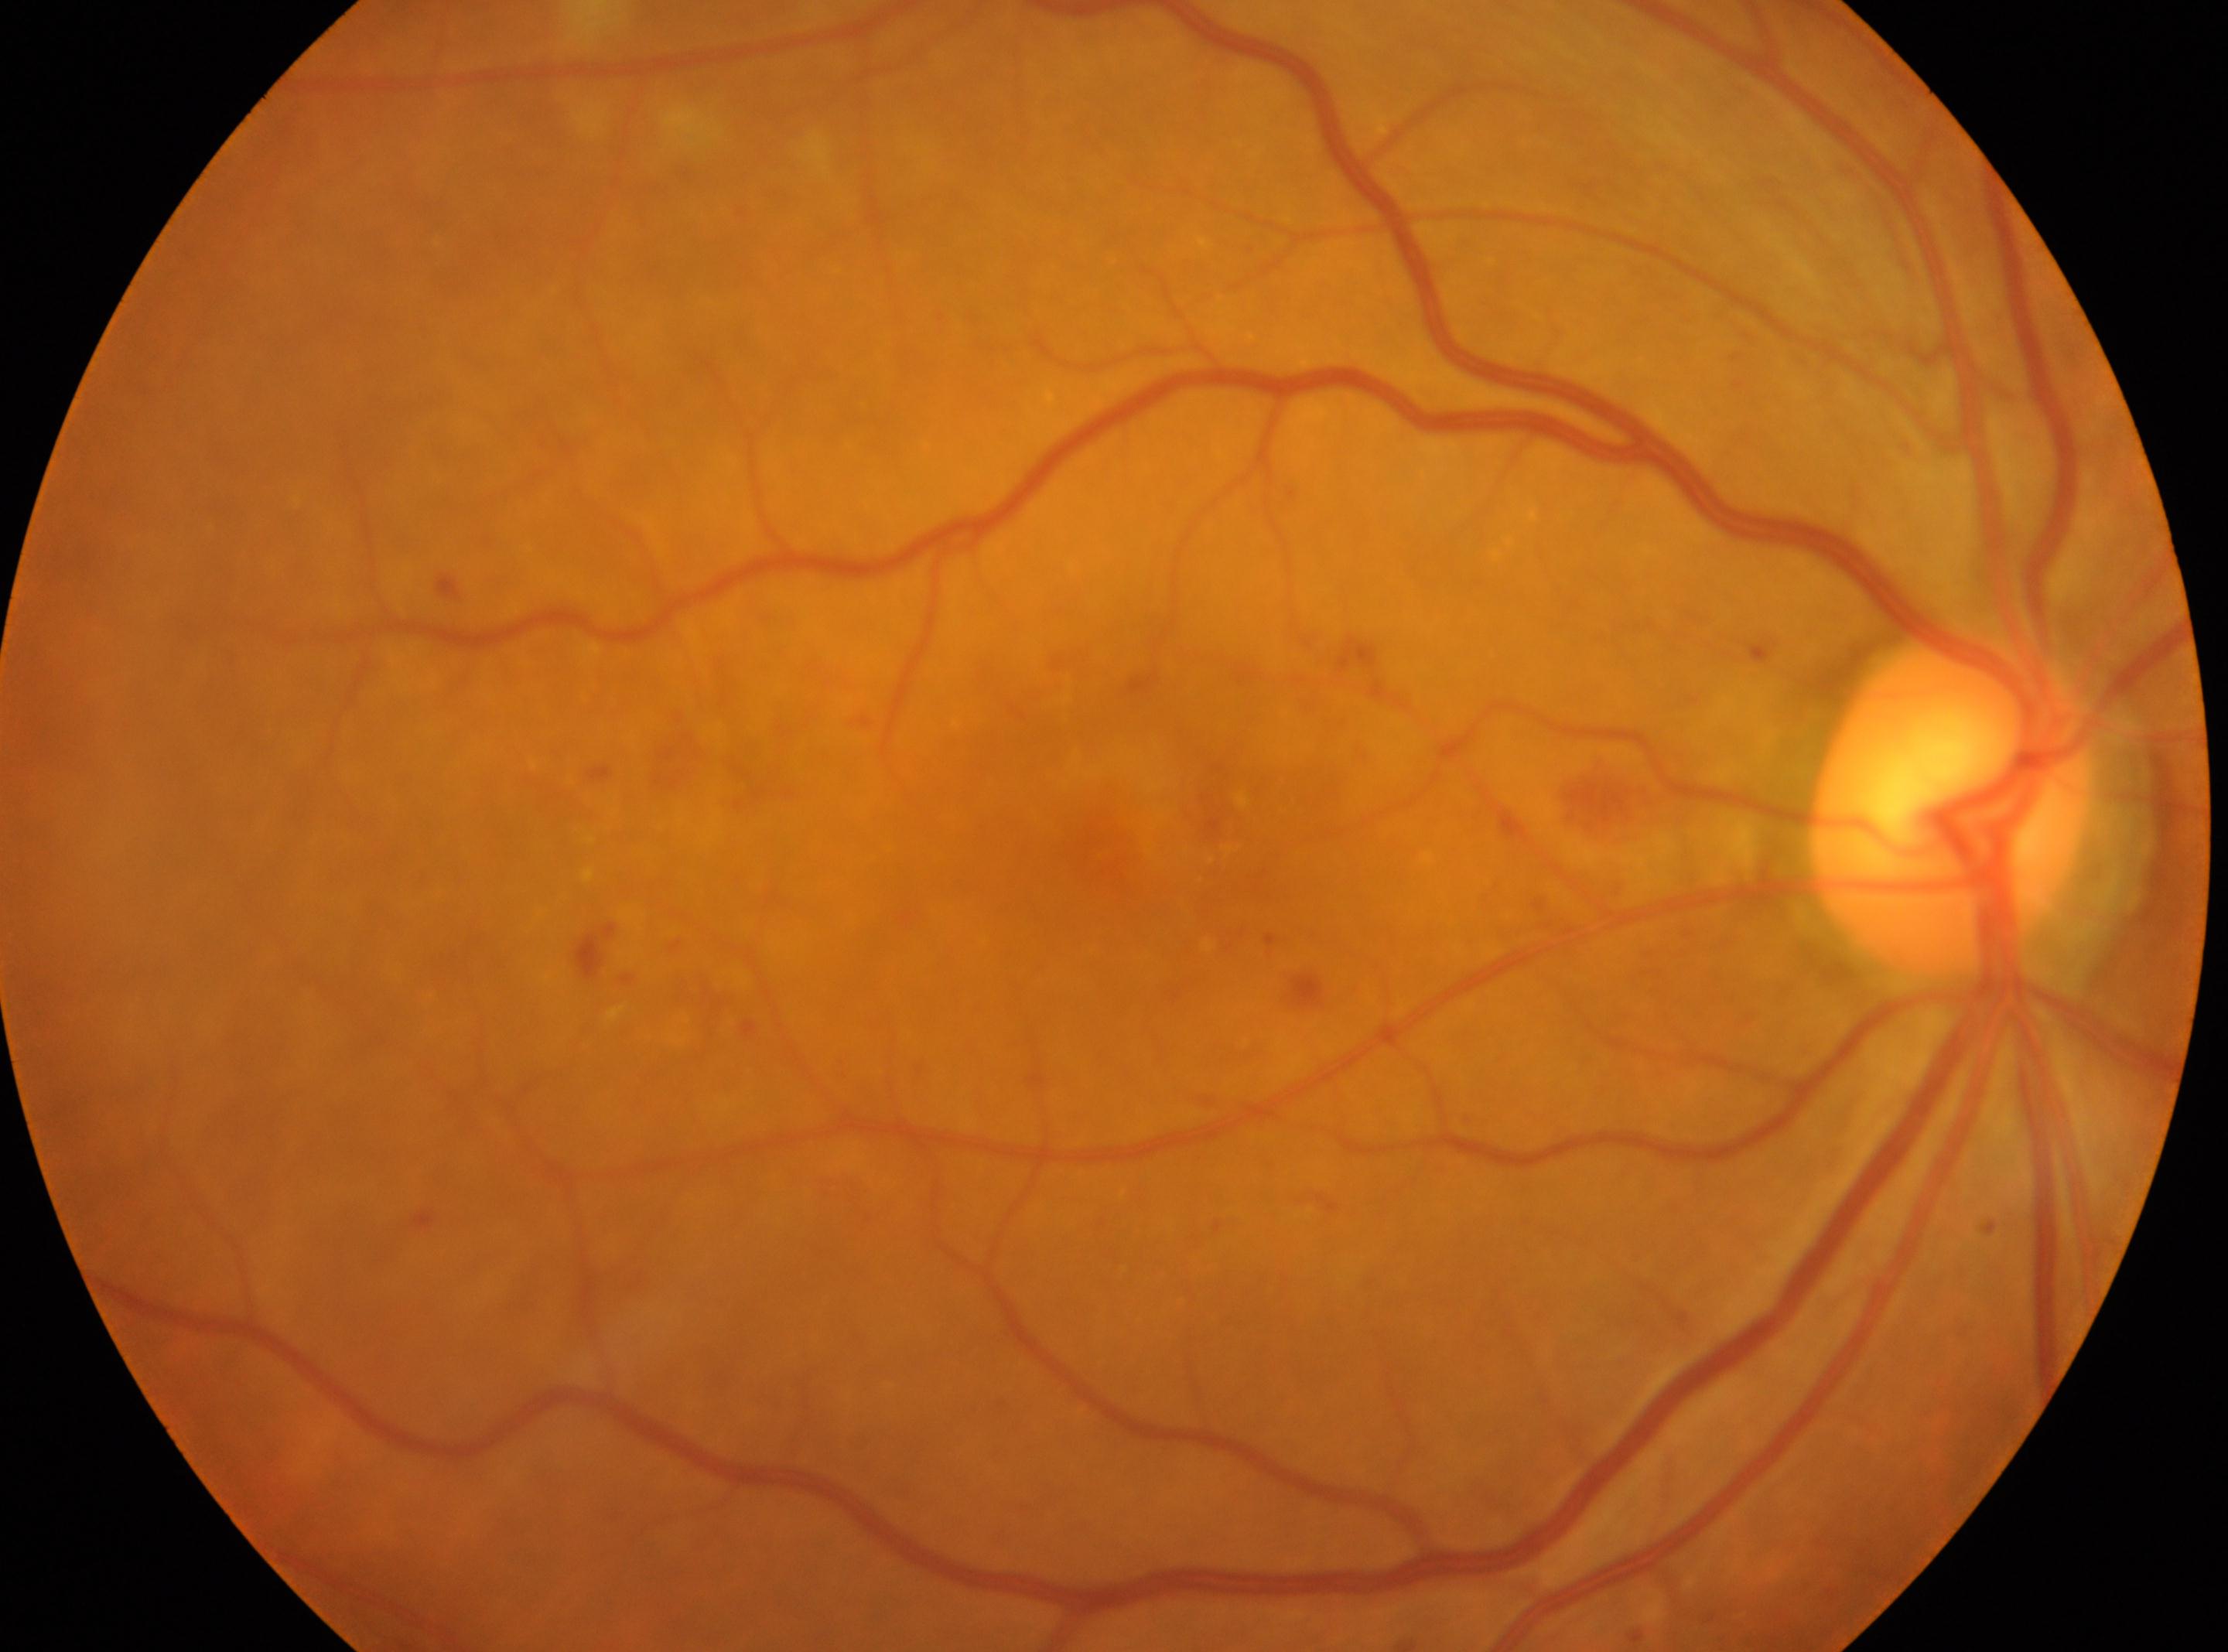 DR stage@grade 2 (moderate NPDR)
optic disc center@x=1950, y=804
OD
the fovea@x=1111, y=854
non-proliferative diabetic retinopathy